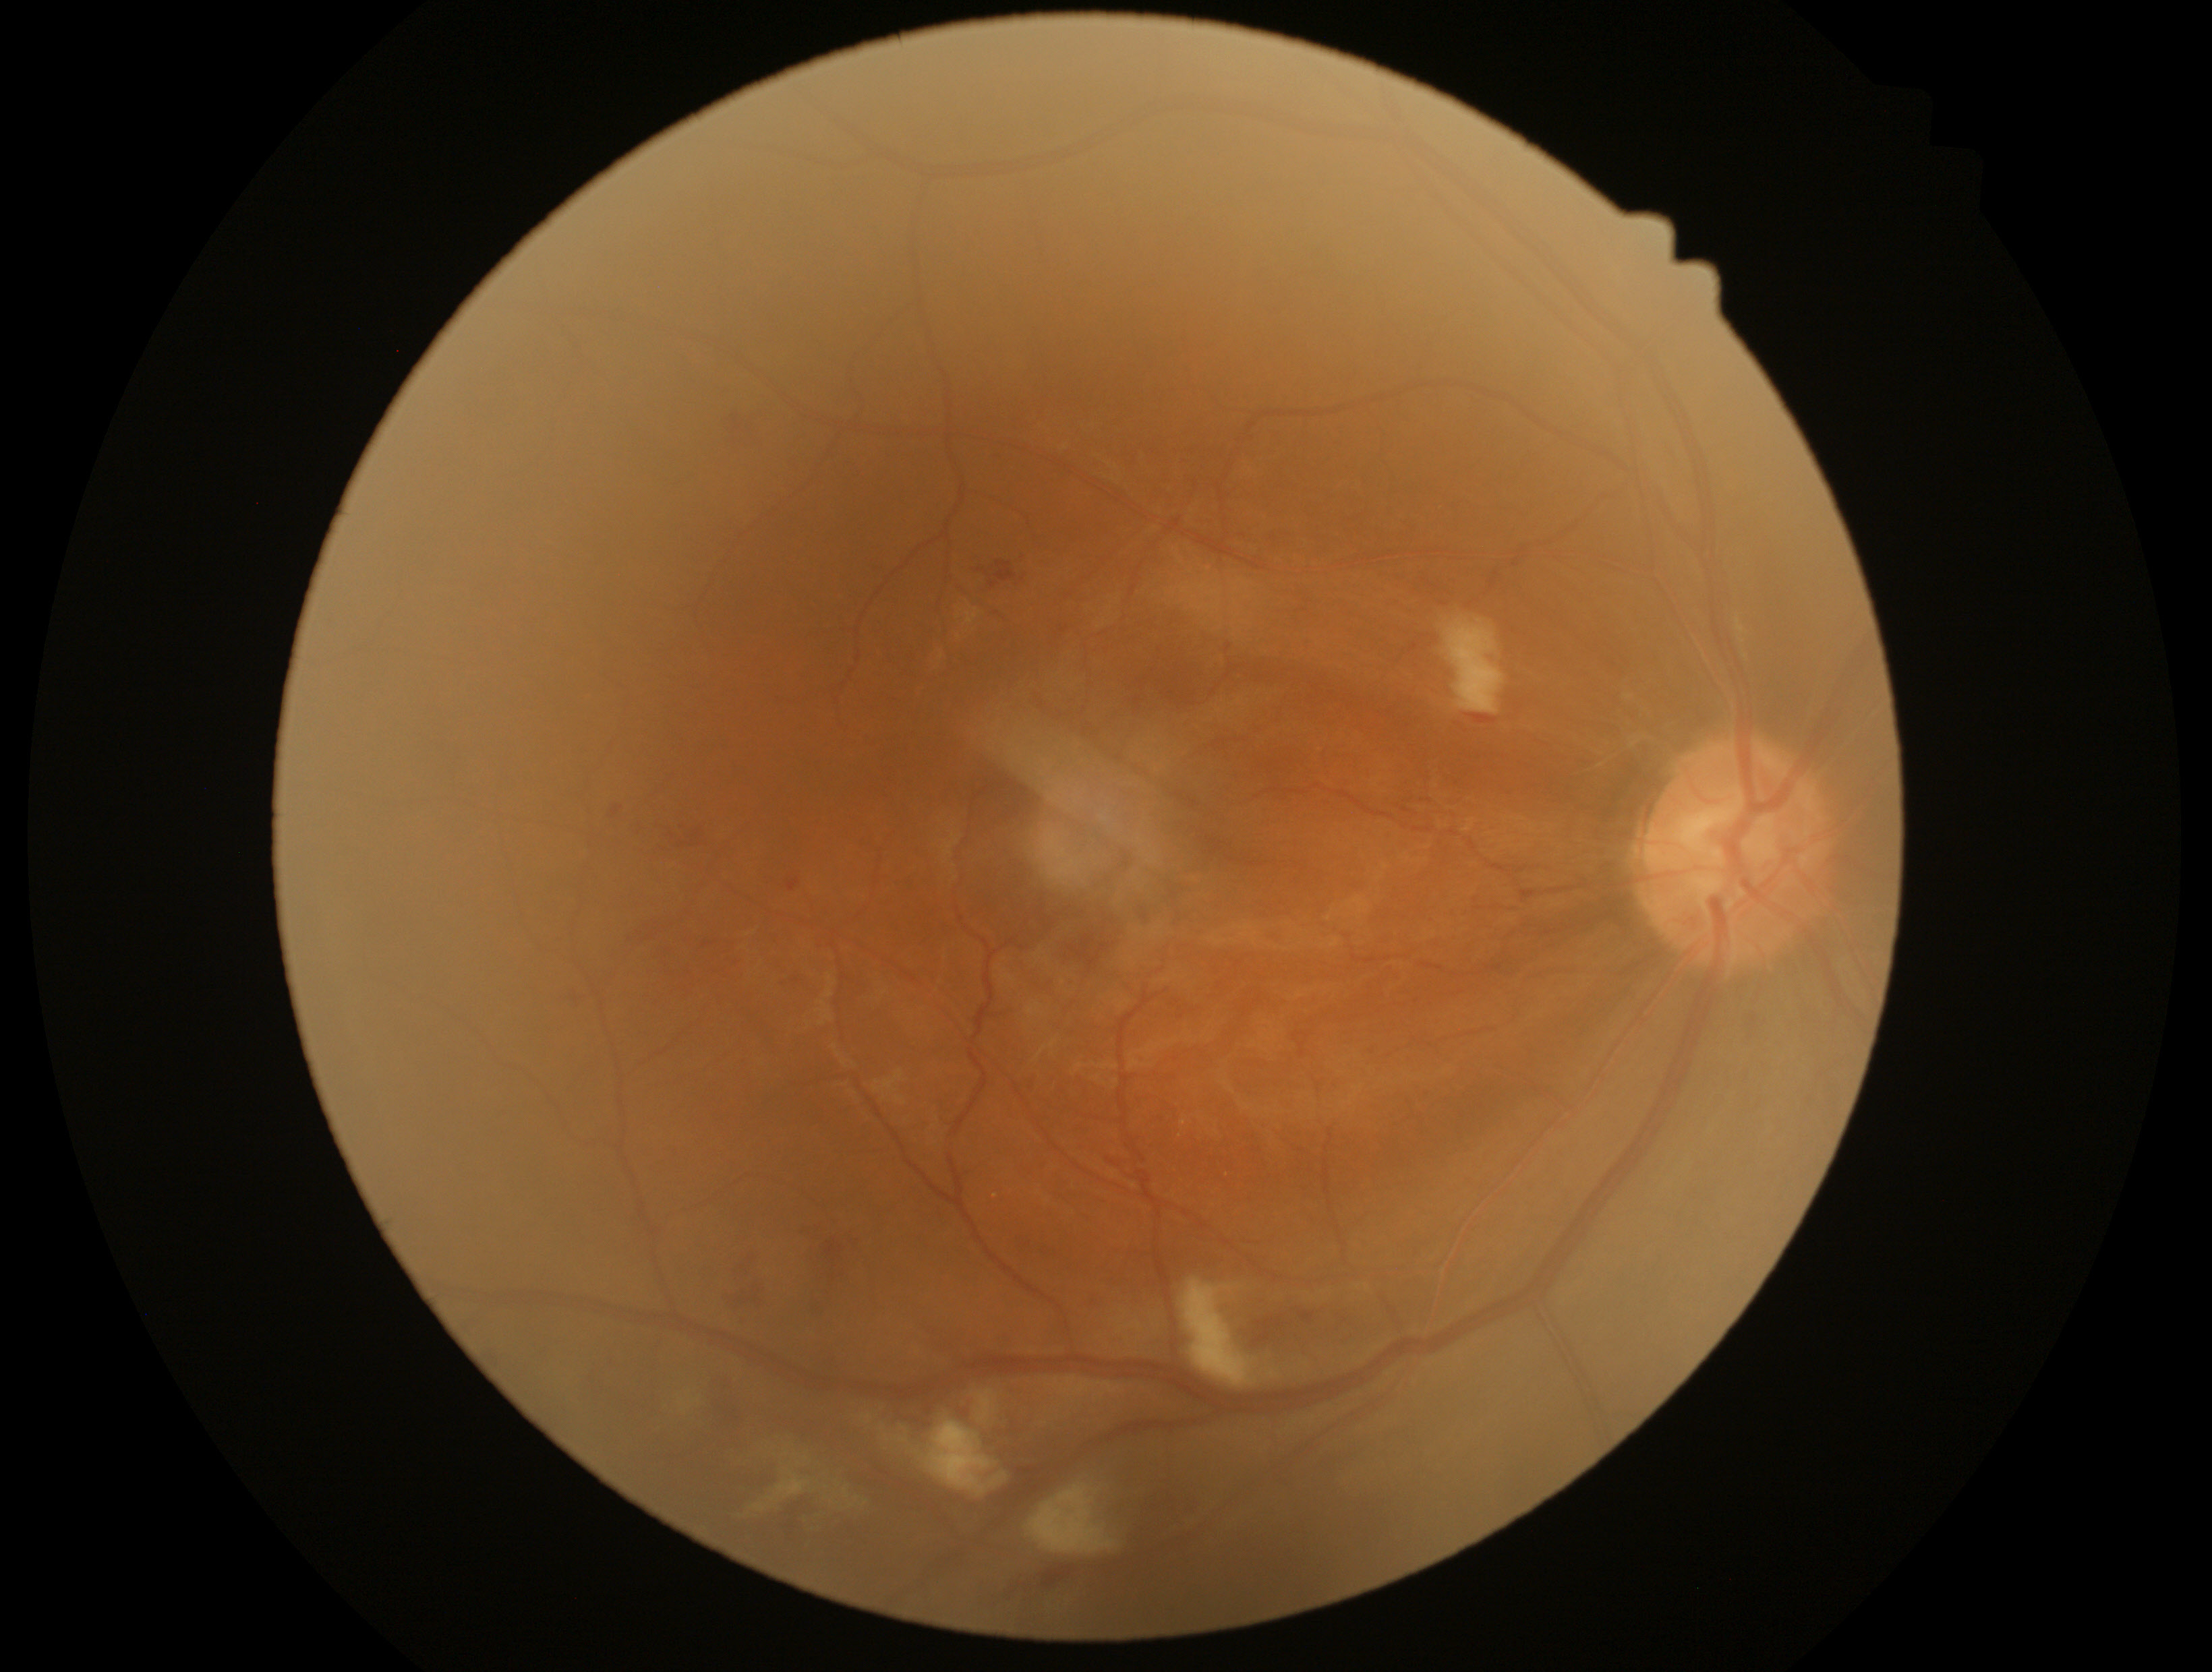

Diabetic retinopathy: moderate non-proliferative diabetic retinopathy (grade 2).